Color fundus image:
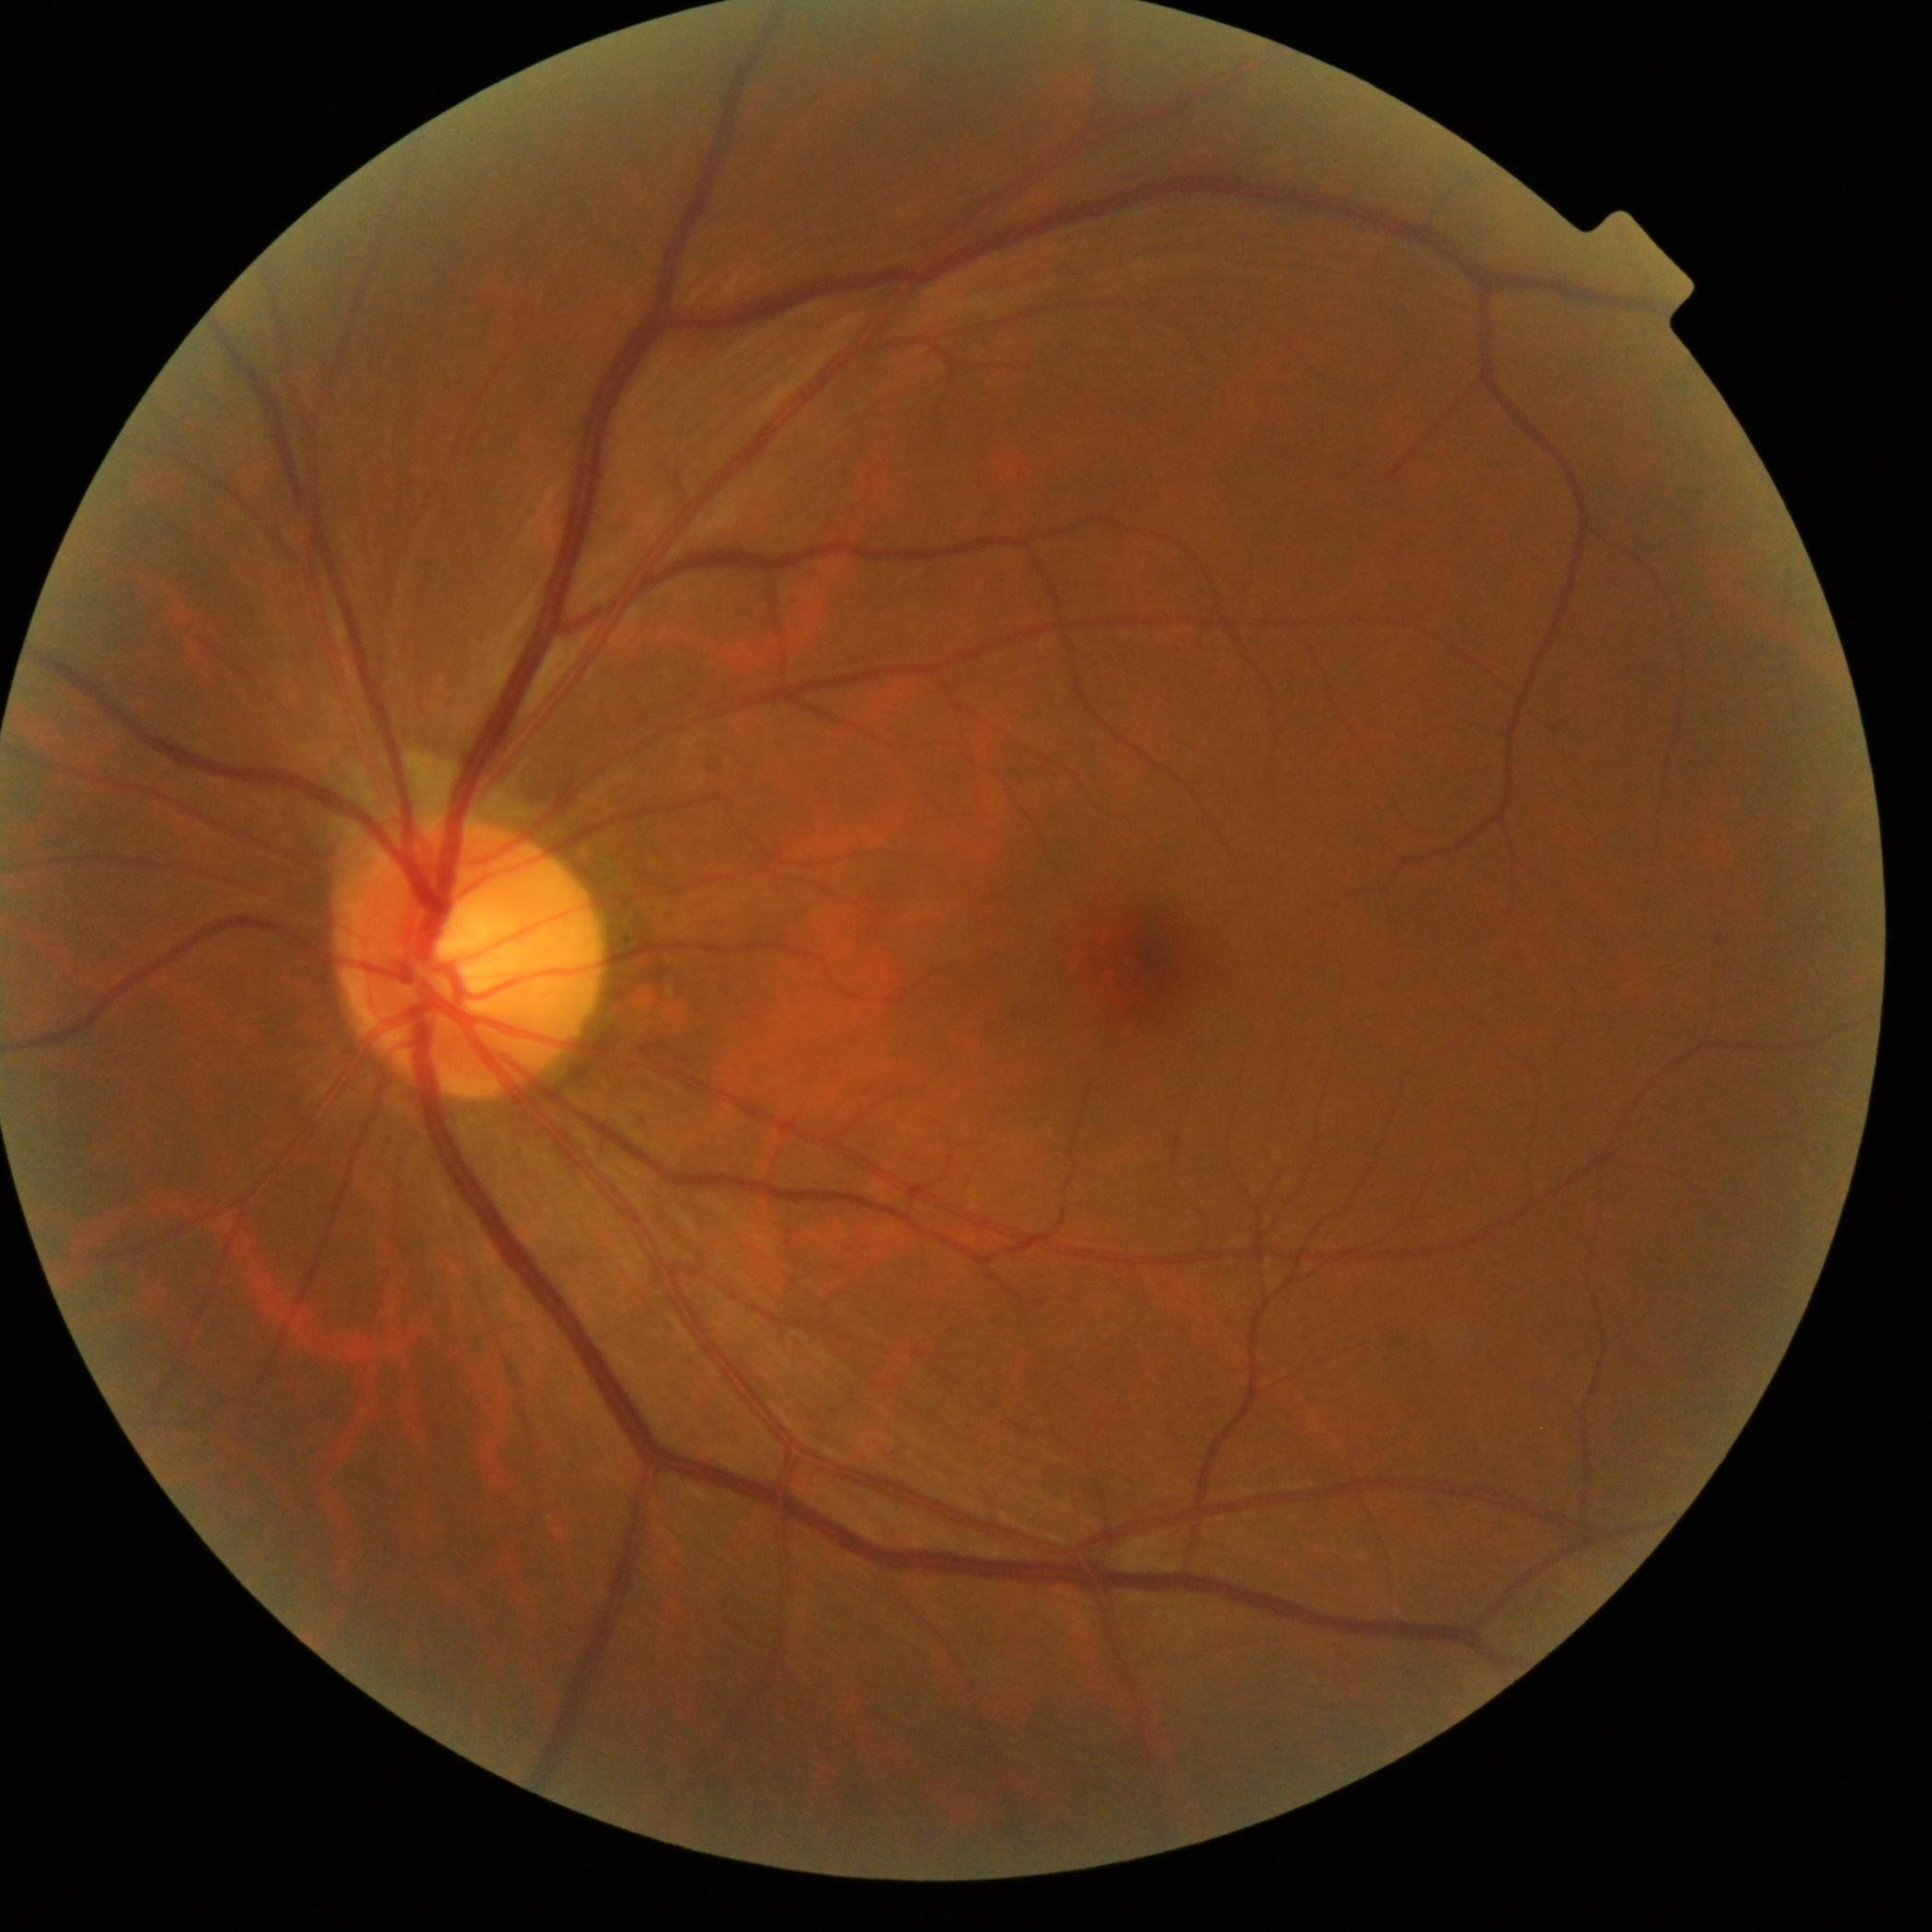
  dr_grade: grade 0